Modified Davis grading: 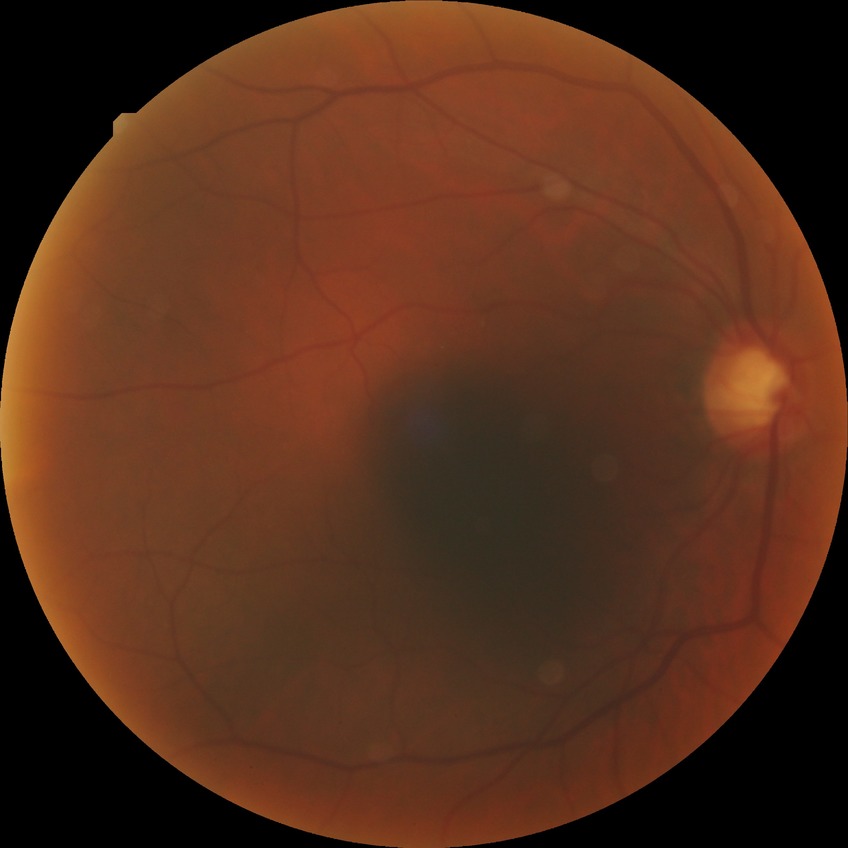 Davis DR grade is NDR.
No DR findings.